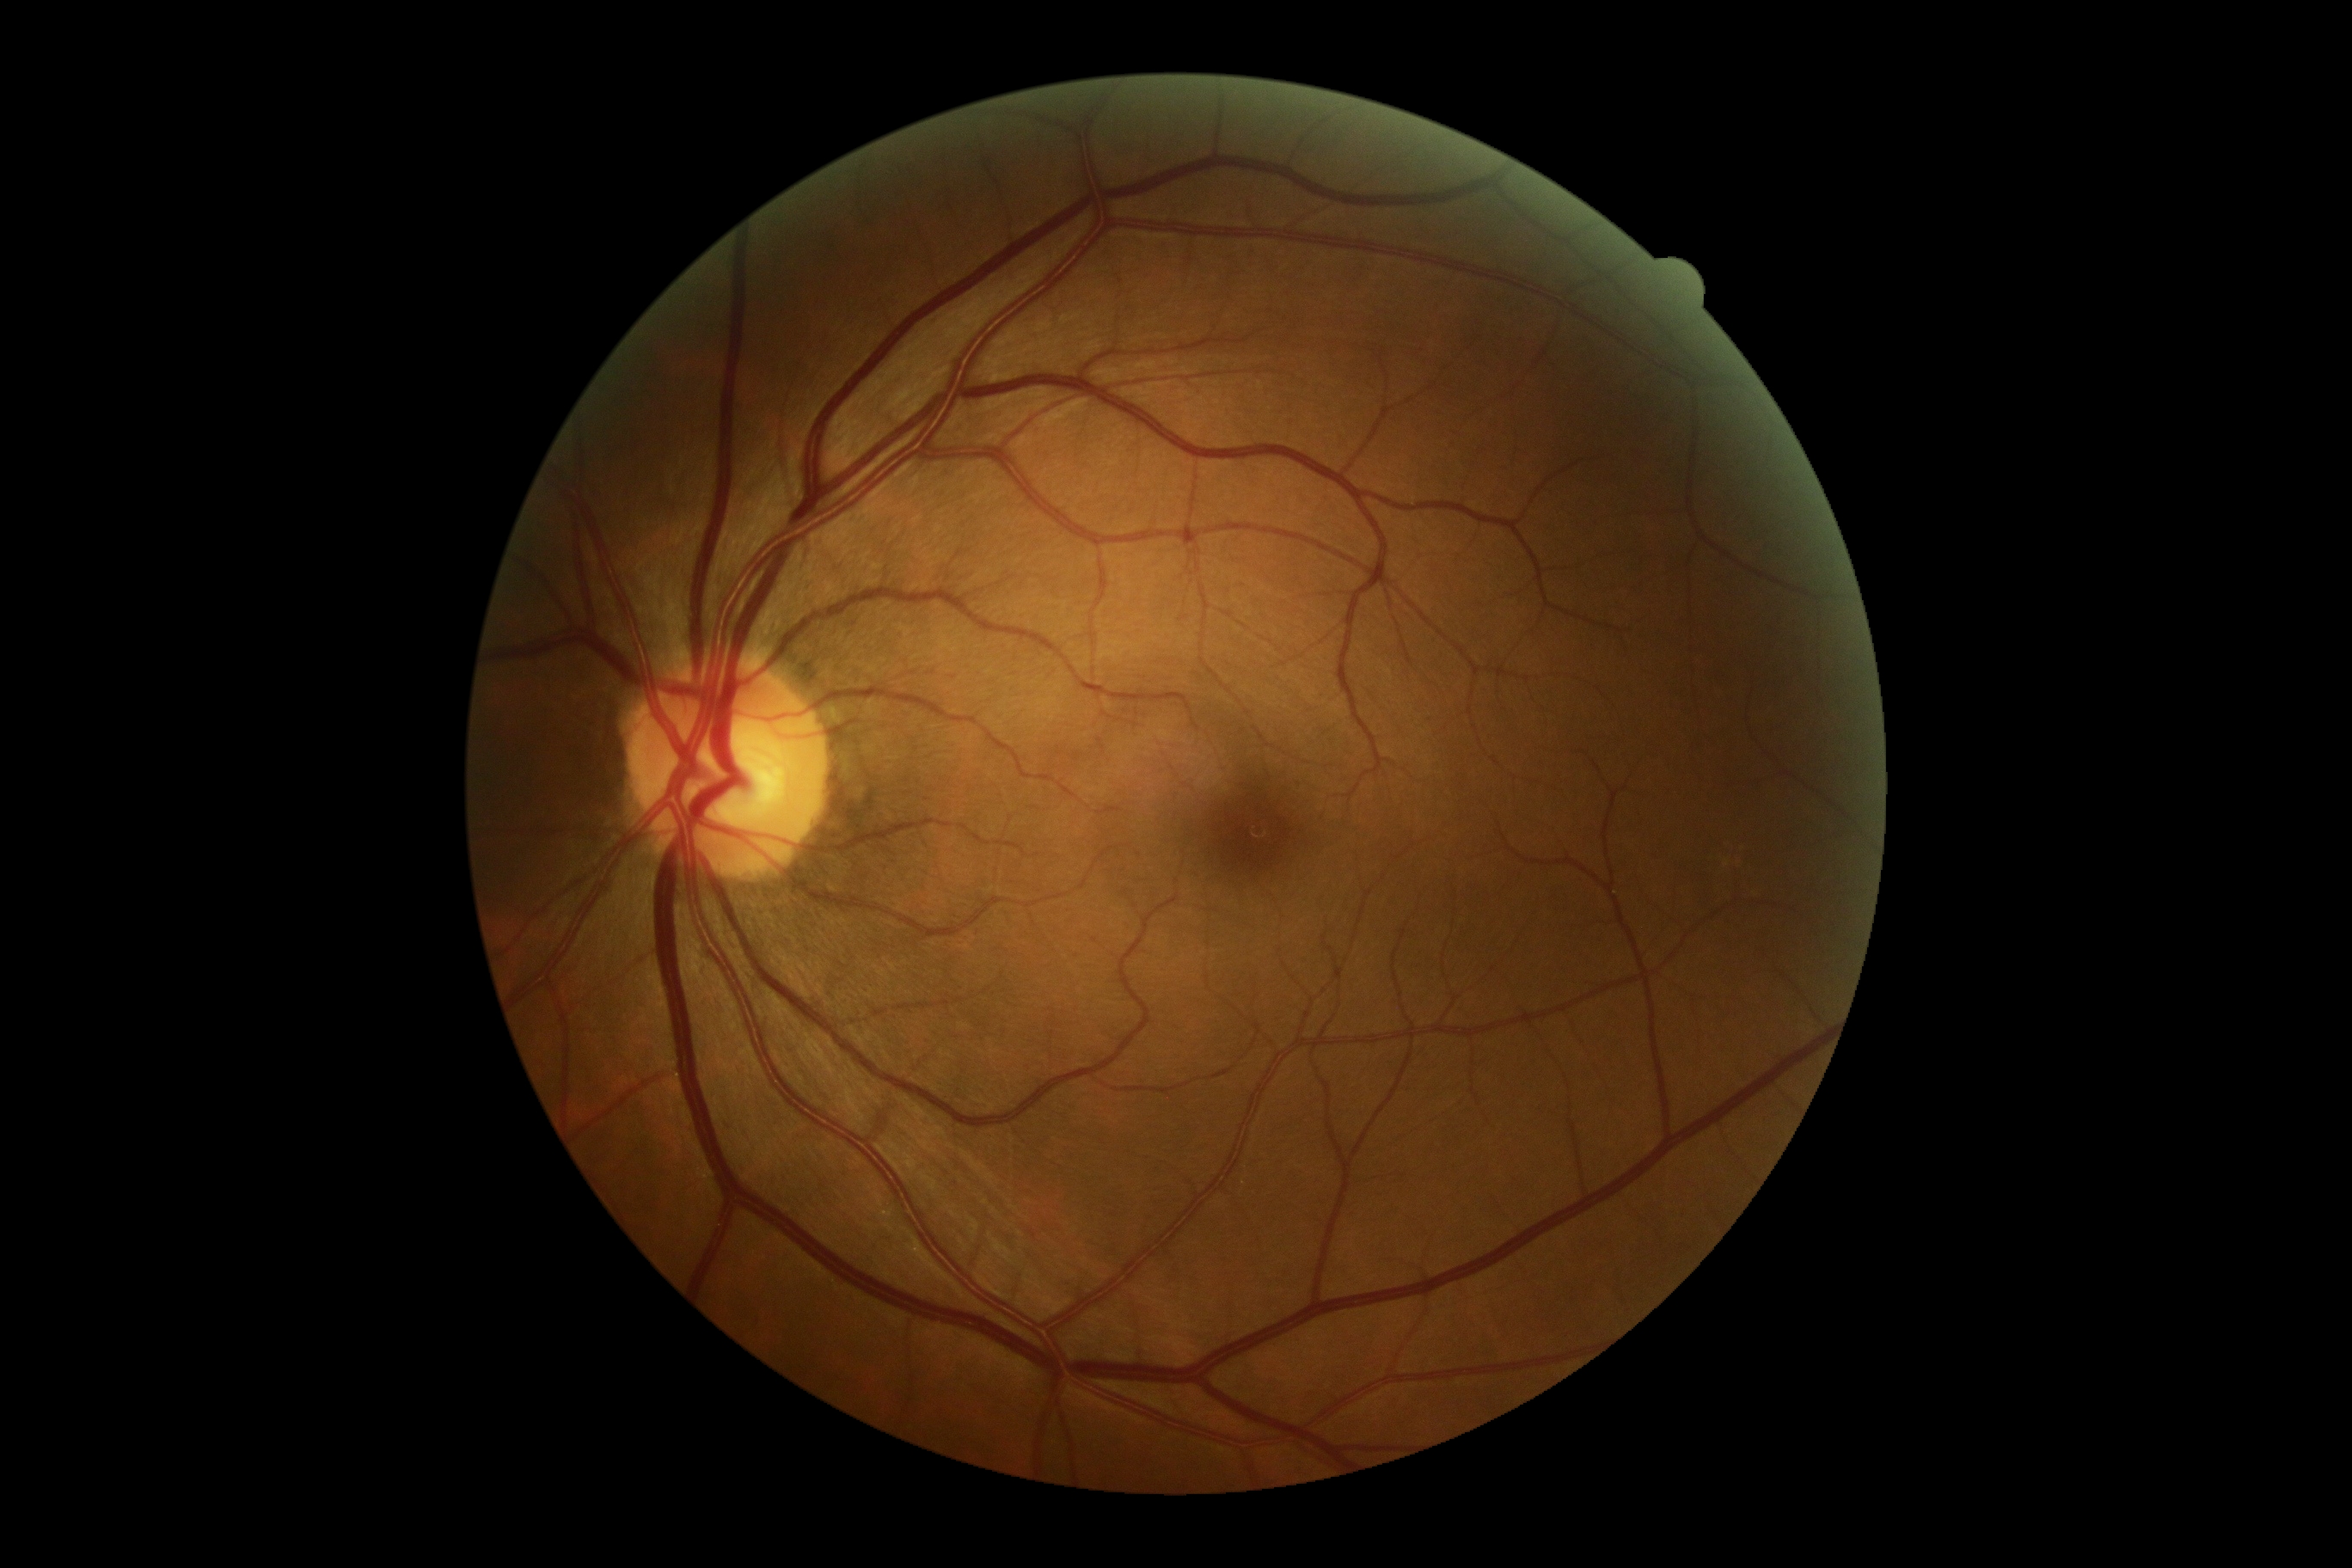

{"dr_grade": "no apparent diabetic retinopathy (grade 0) — no visible signs of diabetic retinopathy", "dr_impression": "negative for DR"}